Color fundus photograph; NIDEK AFC-230; 45° FOV; modified Davis classification:
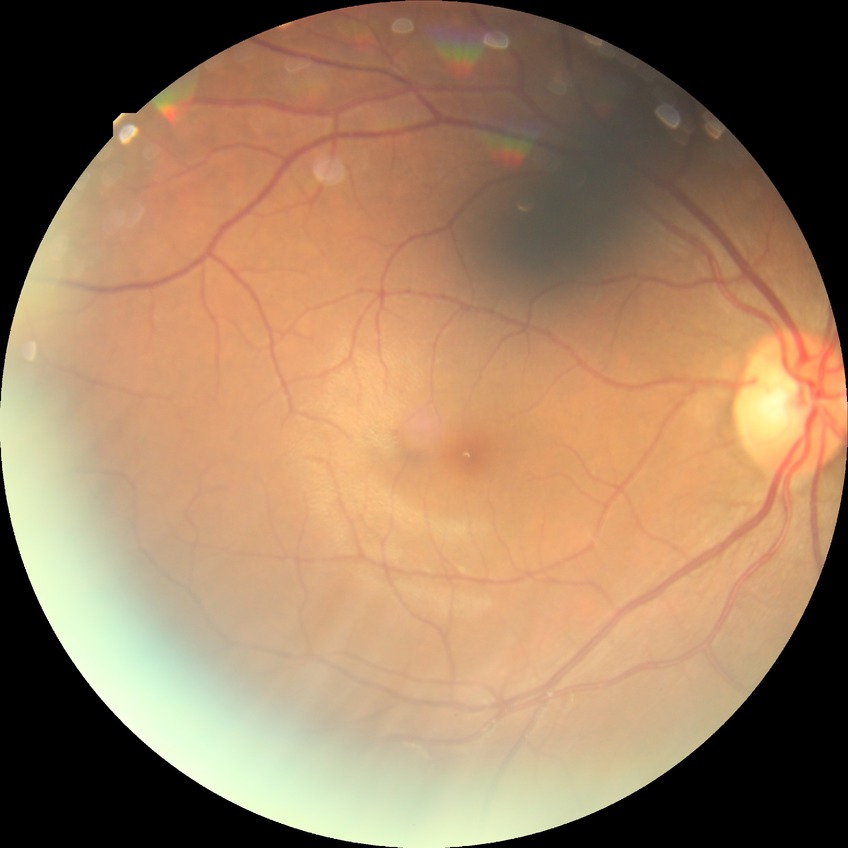

  davis_grade: NDR
  dr_impression: no apparent DR